45° field of view; 2212 by 1659 pixels; CFP:
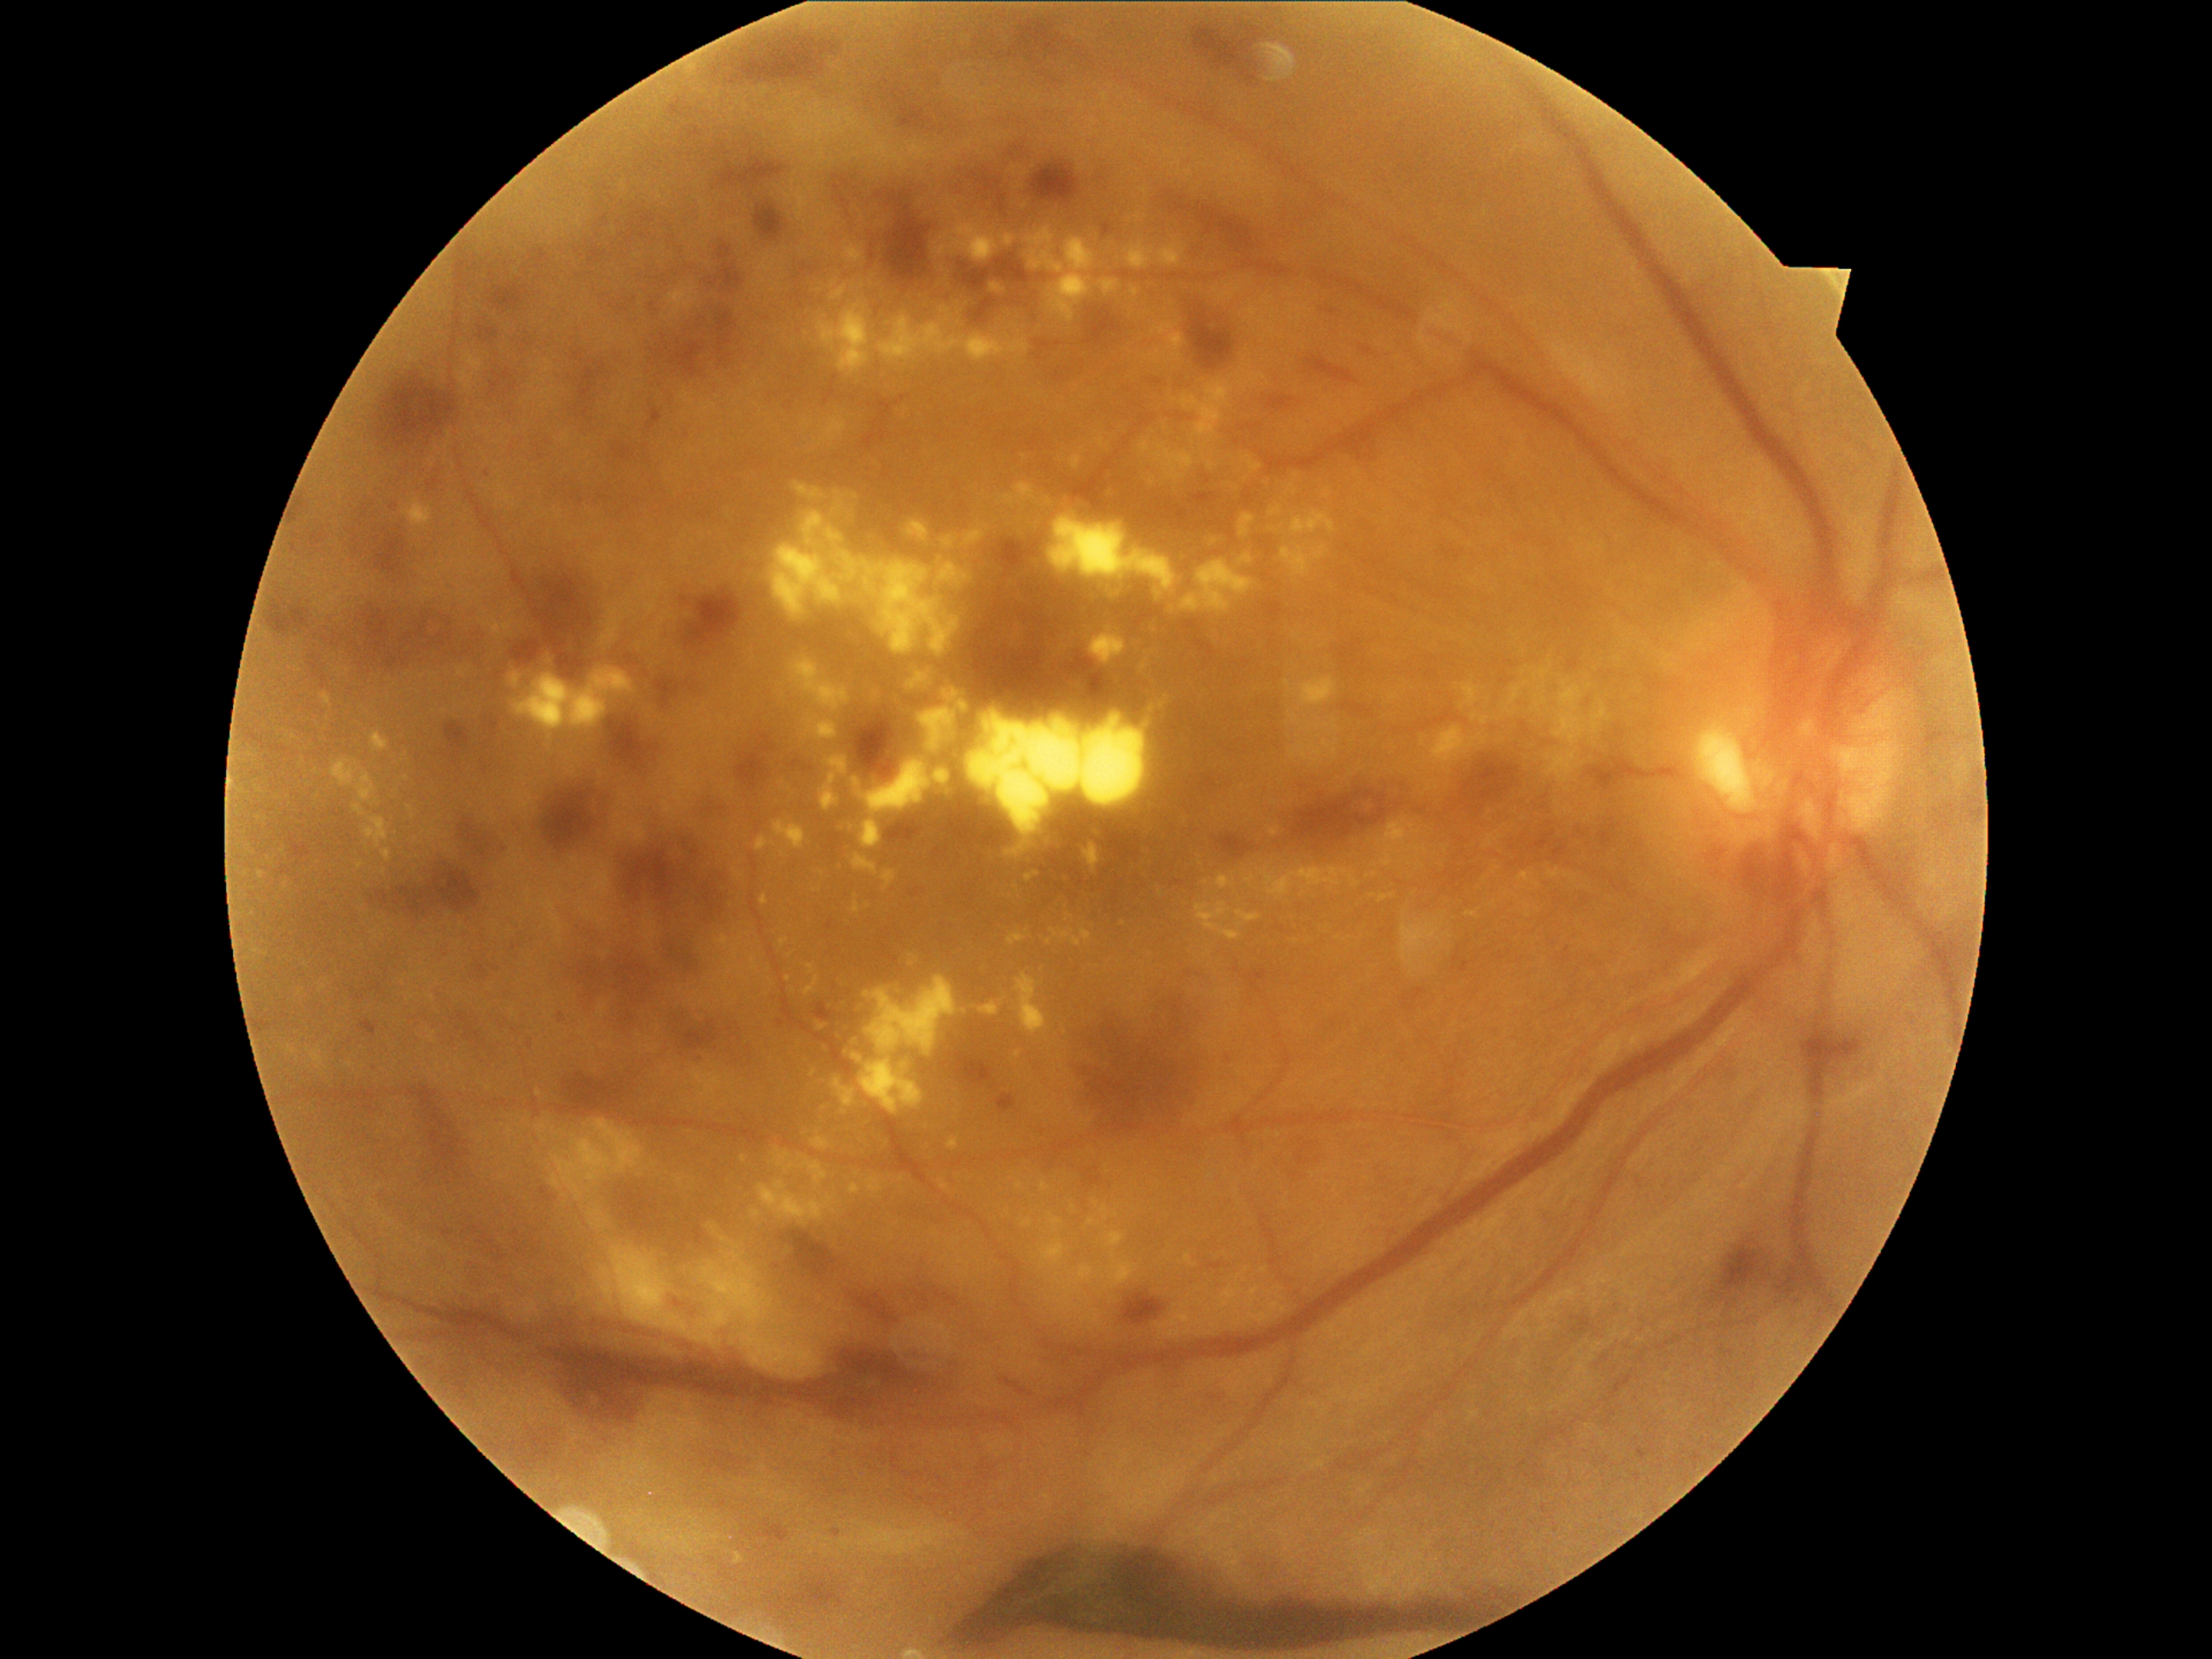

partial: true
dr_grade: 4
lesions:
  ex:
    - {"x1": 1534, "y1": 670, "x2": 1551, "y2": 682}
    - {"x1": 781, "y1": 692, "x2": 786, "y2": 701}
    - {"x1": 1025, "y1": 226, "x2": 1097, "y2": 323}
    - {"x1": 1015, "y1": 974, "x2": 1049, "y2": 1035}
    - {"x1": 948, "y1": 1138, "x2": 960, "y2": 1150}
    - {"x1": 834, "y1": 1078, "x2": 858, "y2": 1109}
    - {"x1": 808, "y1": 965, "x2": 817, "y2": 975}
    - {"x1": 1301, "y1": 723, "x2": 1329, "y2": 740}
    - {"x1": 1057, "y1": 1266, "x2": 1093, "y2": 1300}
    - {"x1": 1465, "y1": 911, "x2": 1479, "y2": 919}
    - {"x1": 1016, "y1": 1182, "x2": 1023, "y2": 1190}
    - {"x1": 868, "y1": 1177, "x2": 887, "y2": 1194}
    - {"x1": 1016, "y1": 484, "x2": 1033, "y2": 499}
  ex_small_centers:
    - [x=792, y=955]
    - [x=1008, y=1213]
    - [x=1096, y=1204]
    - [x=1207, y=882]
    - [x=1596, y=708]
    - [x=1412, y=972]
    - [x=1281, y=1298]